Captured on a Remidio Fundus on Phone (FOP) camera: 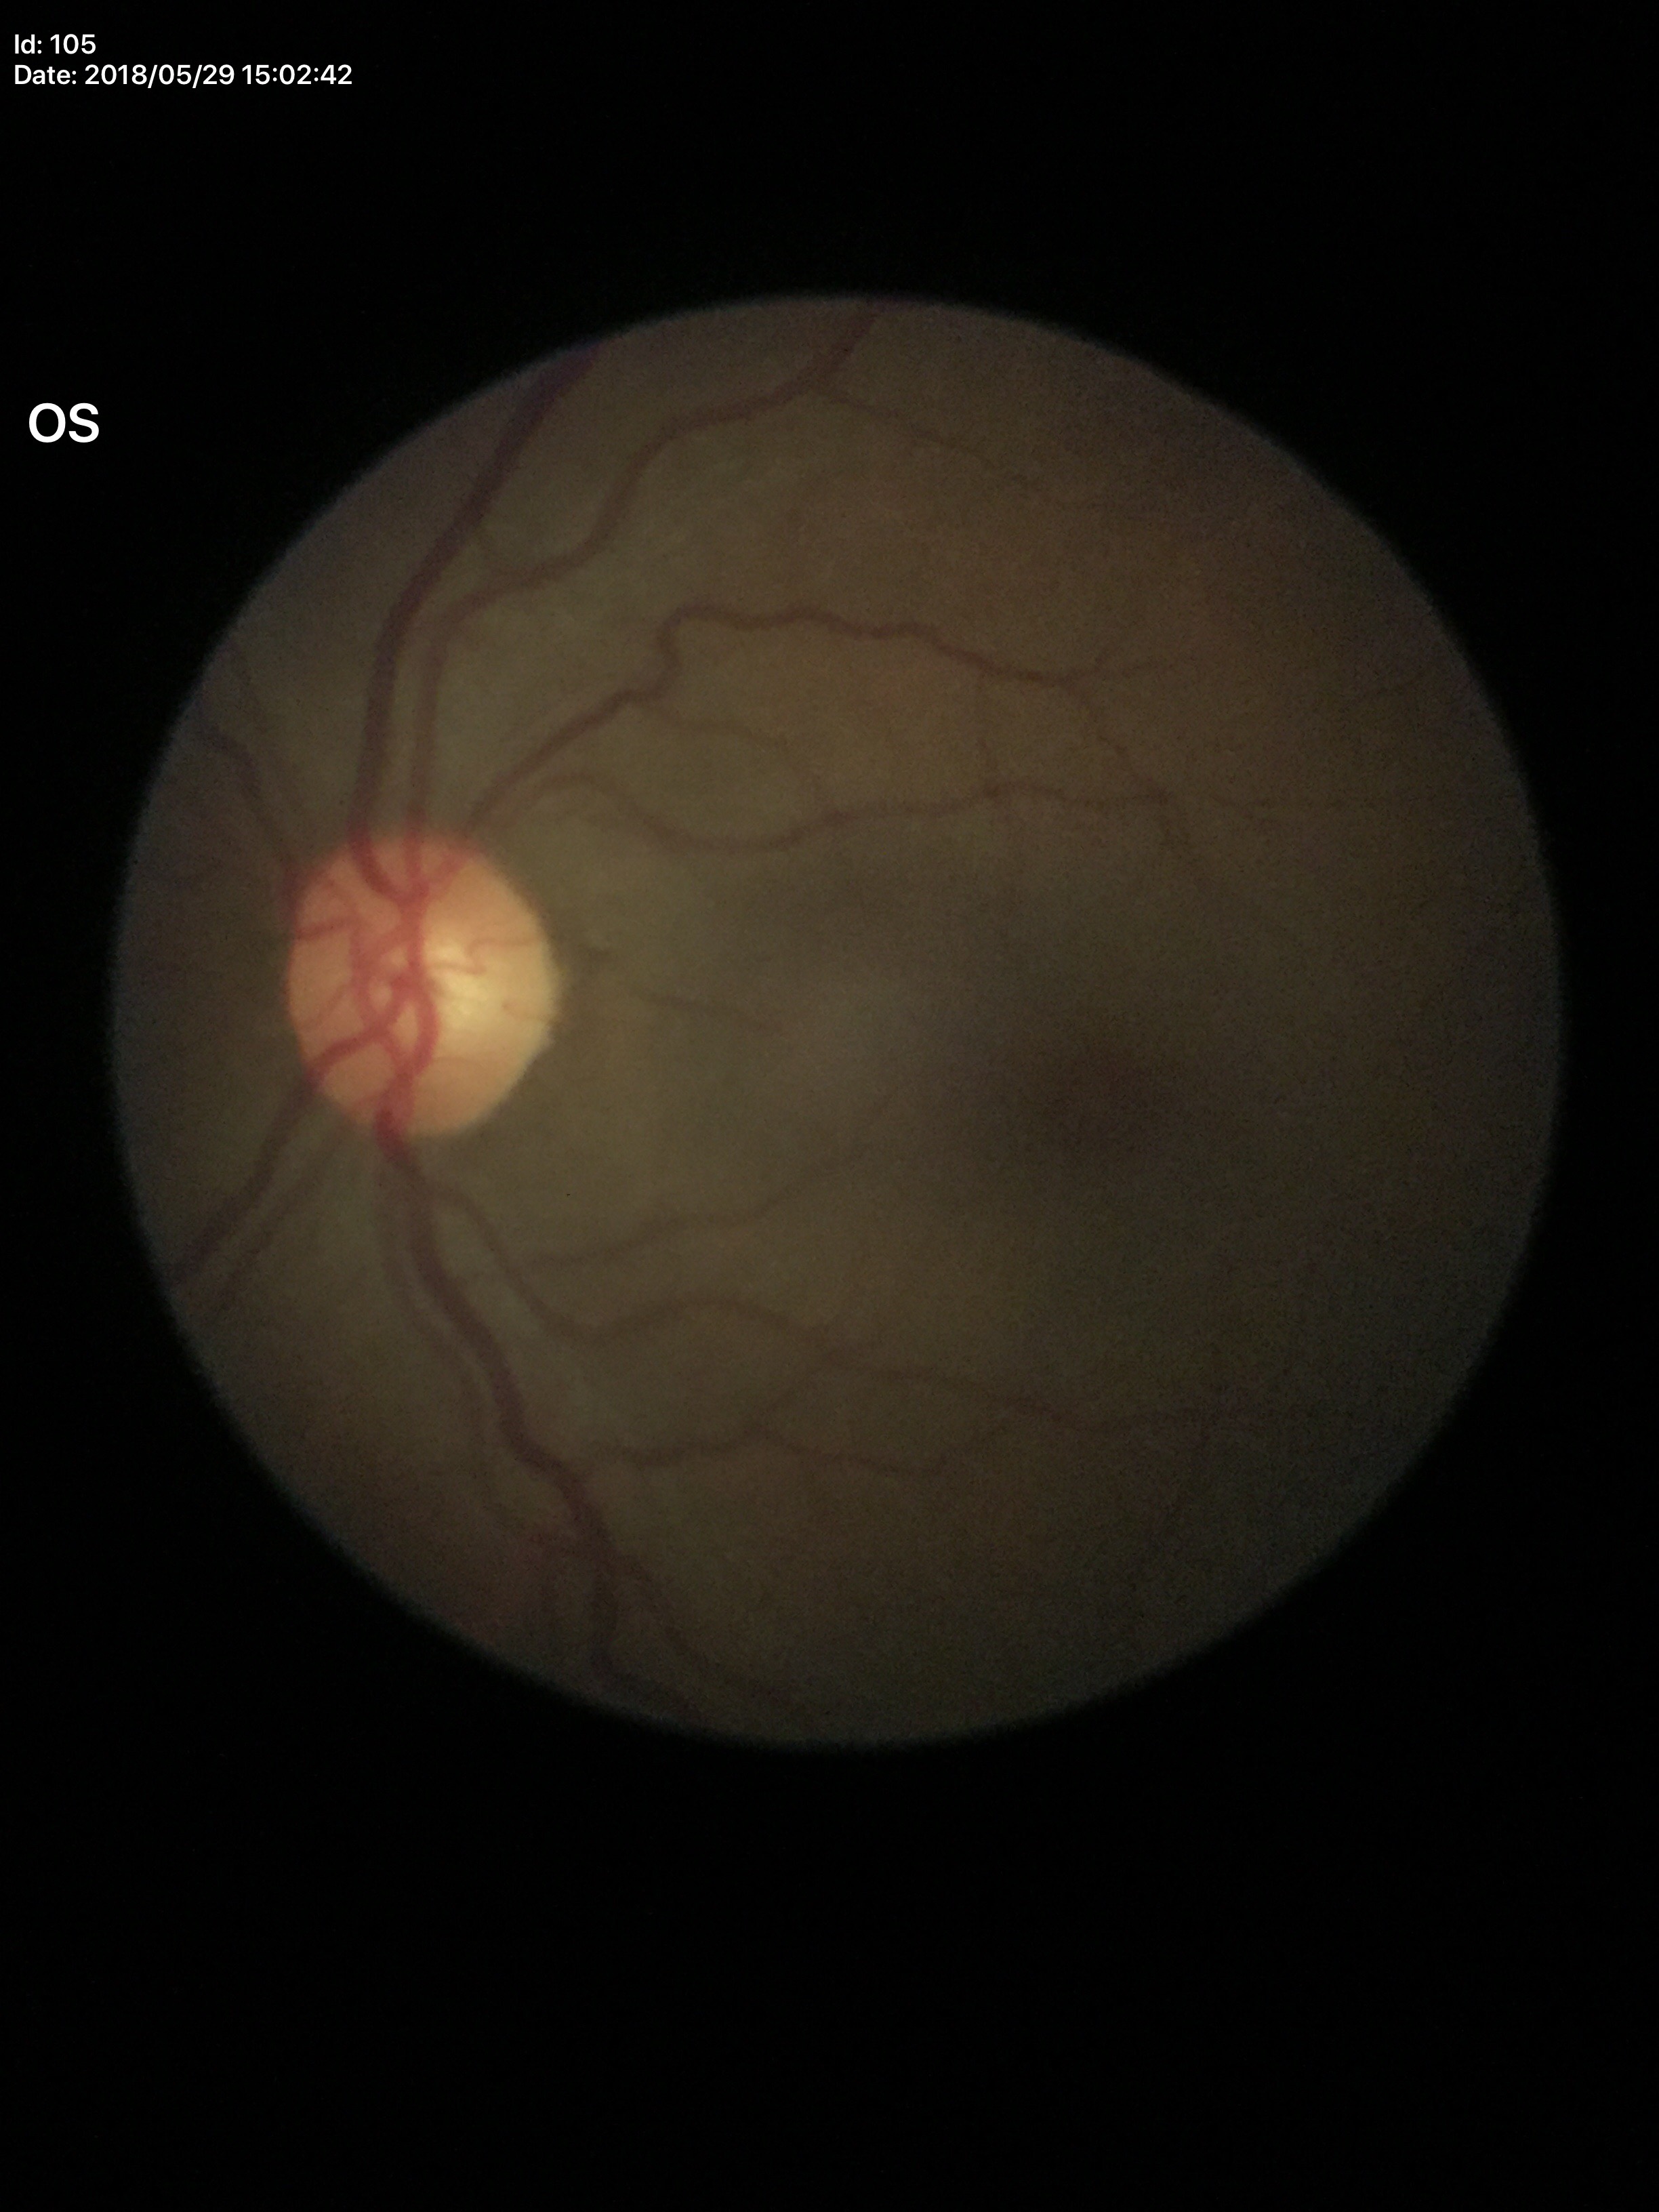 No evidence of glaucoma (5/5 ophthalmologists in agreement). VCDR is 0.52.